Retinal fundus photograph — 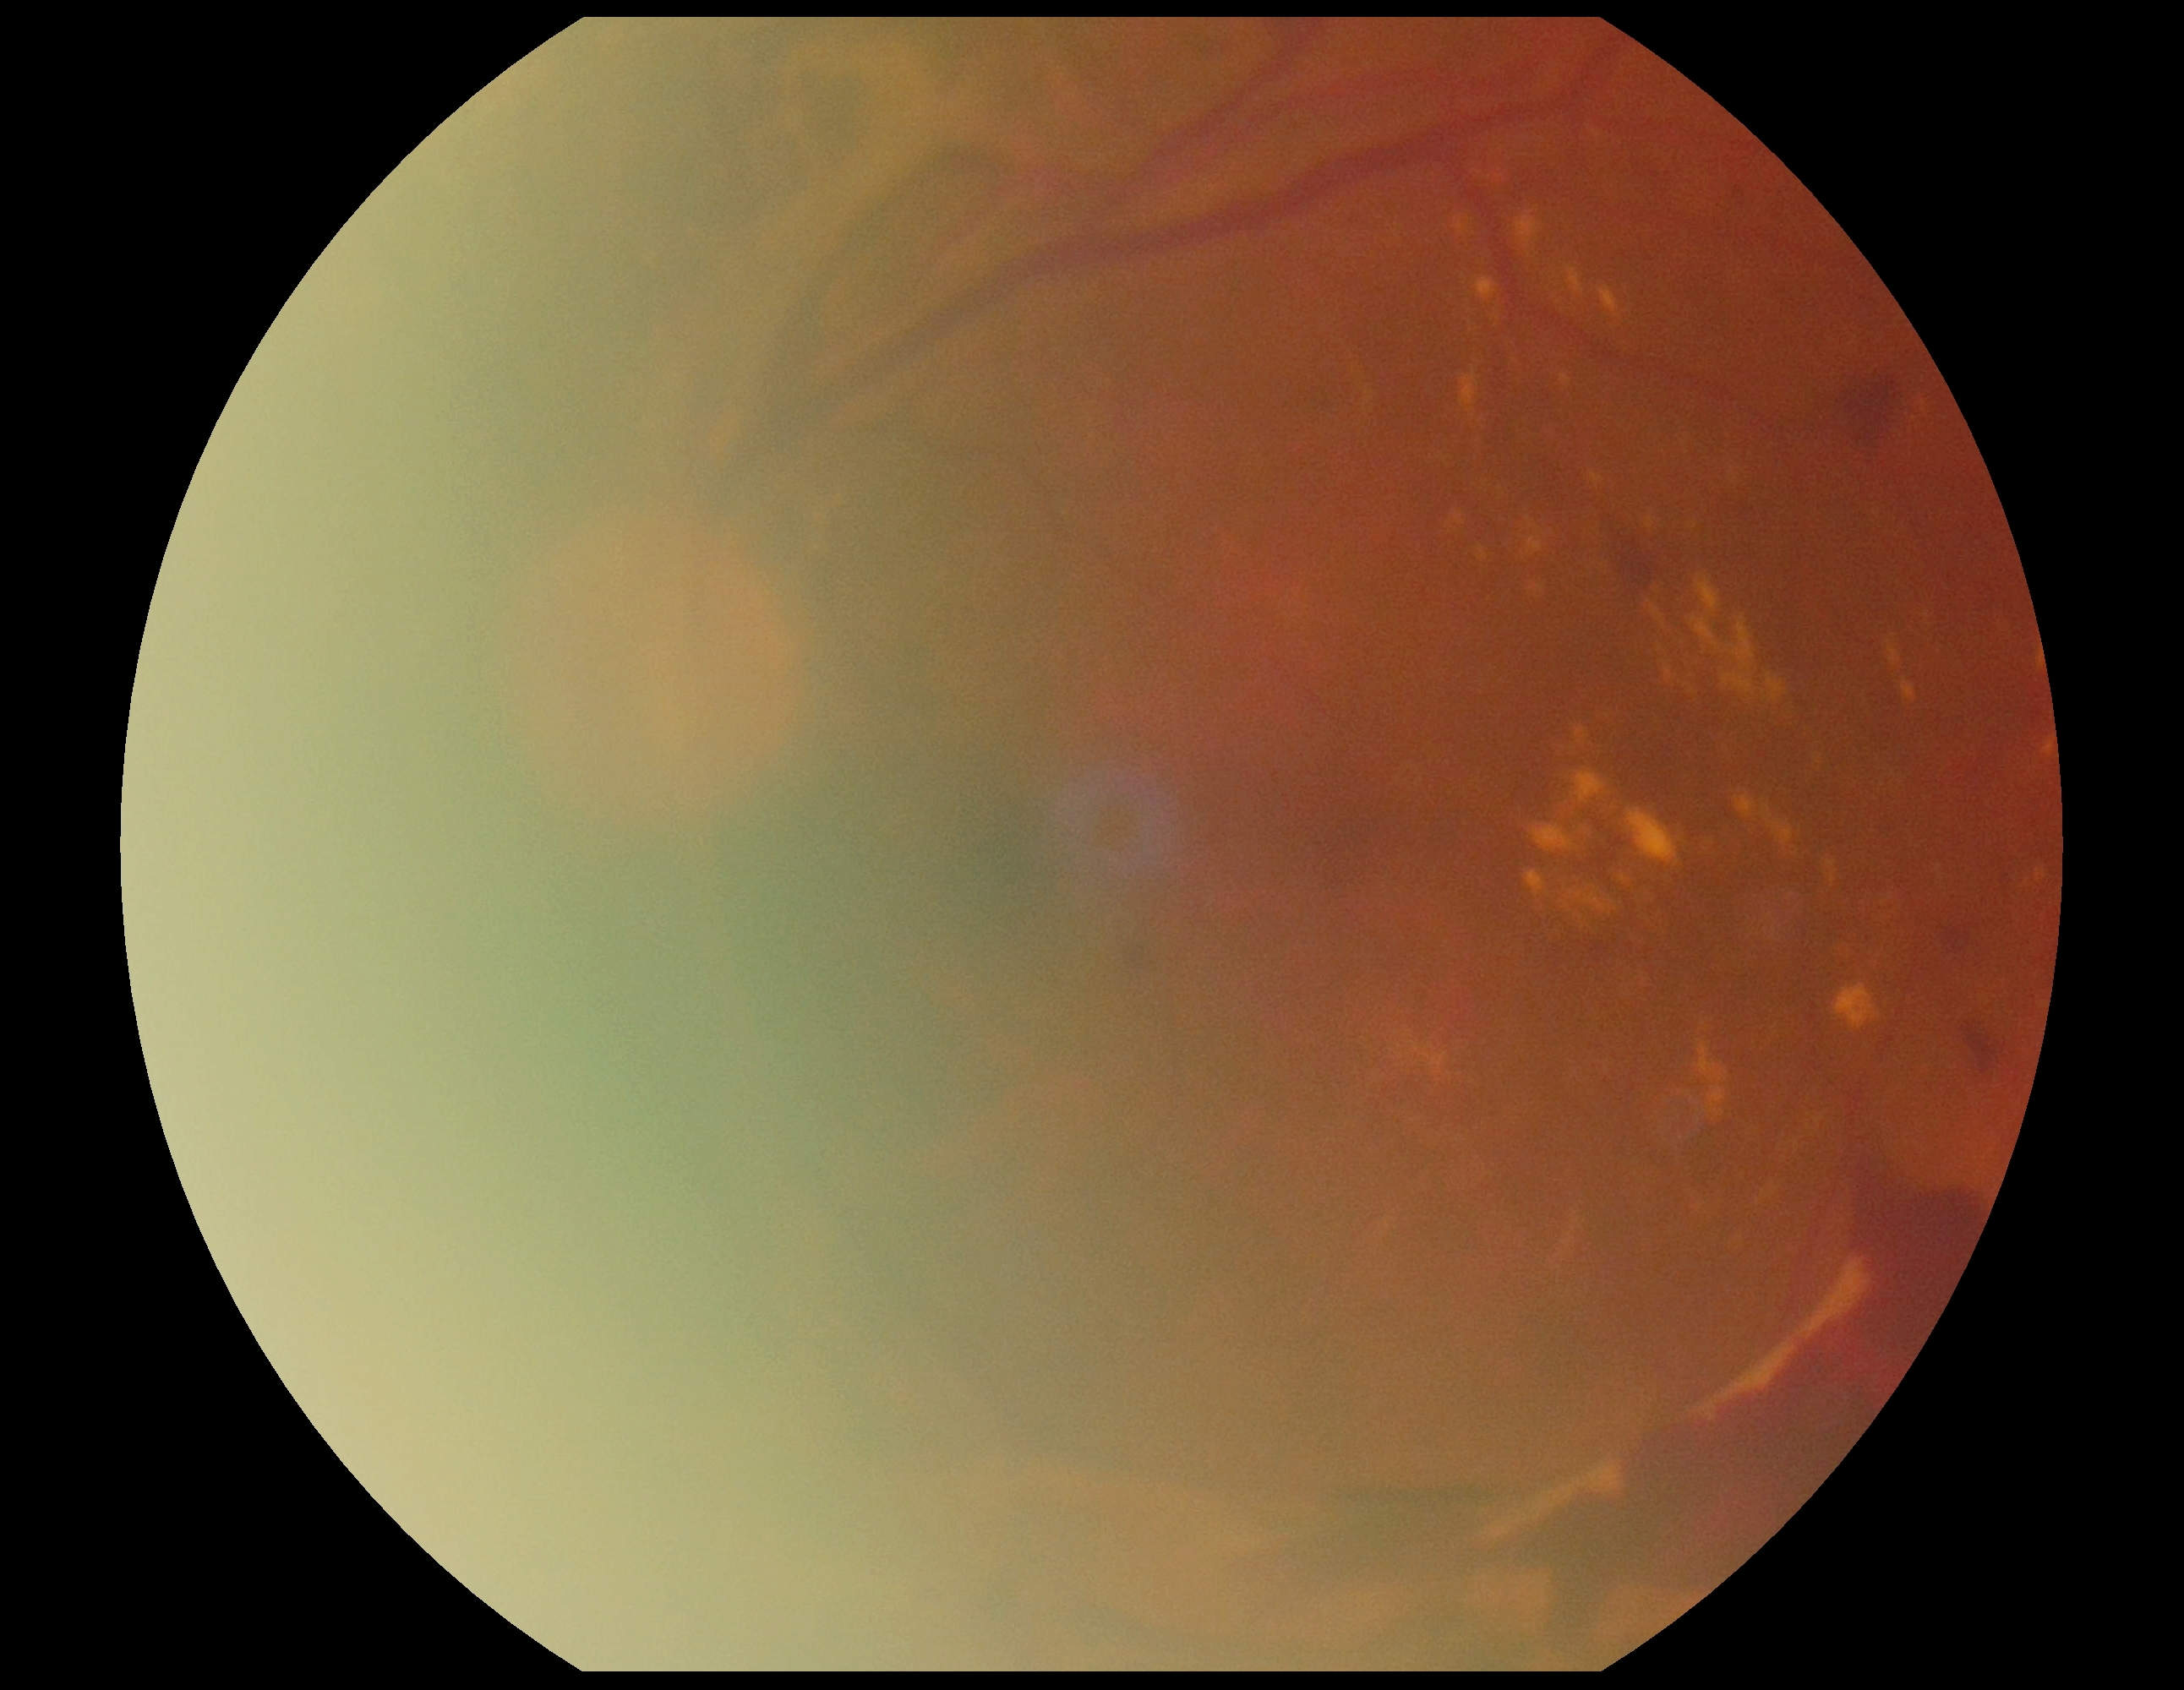 DR grade: proliferative diabetic retinopathy (4).